Color fundus image; 45-degree field of view.
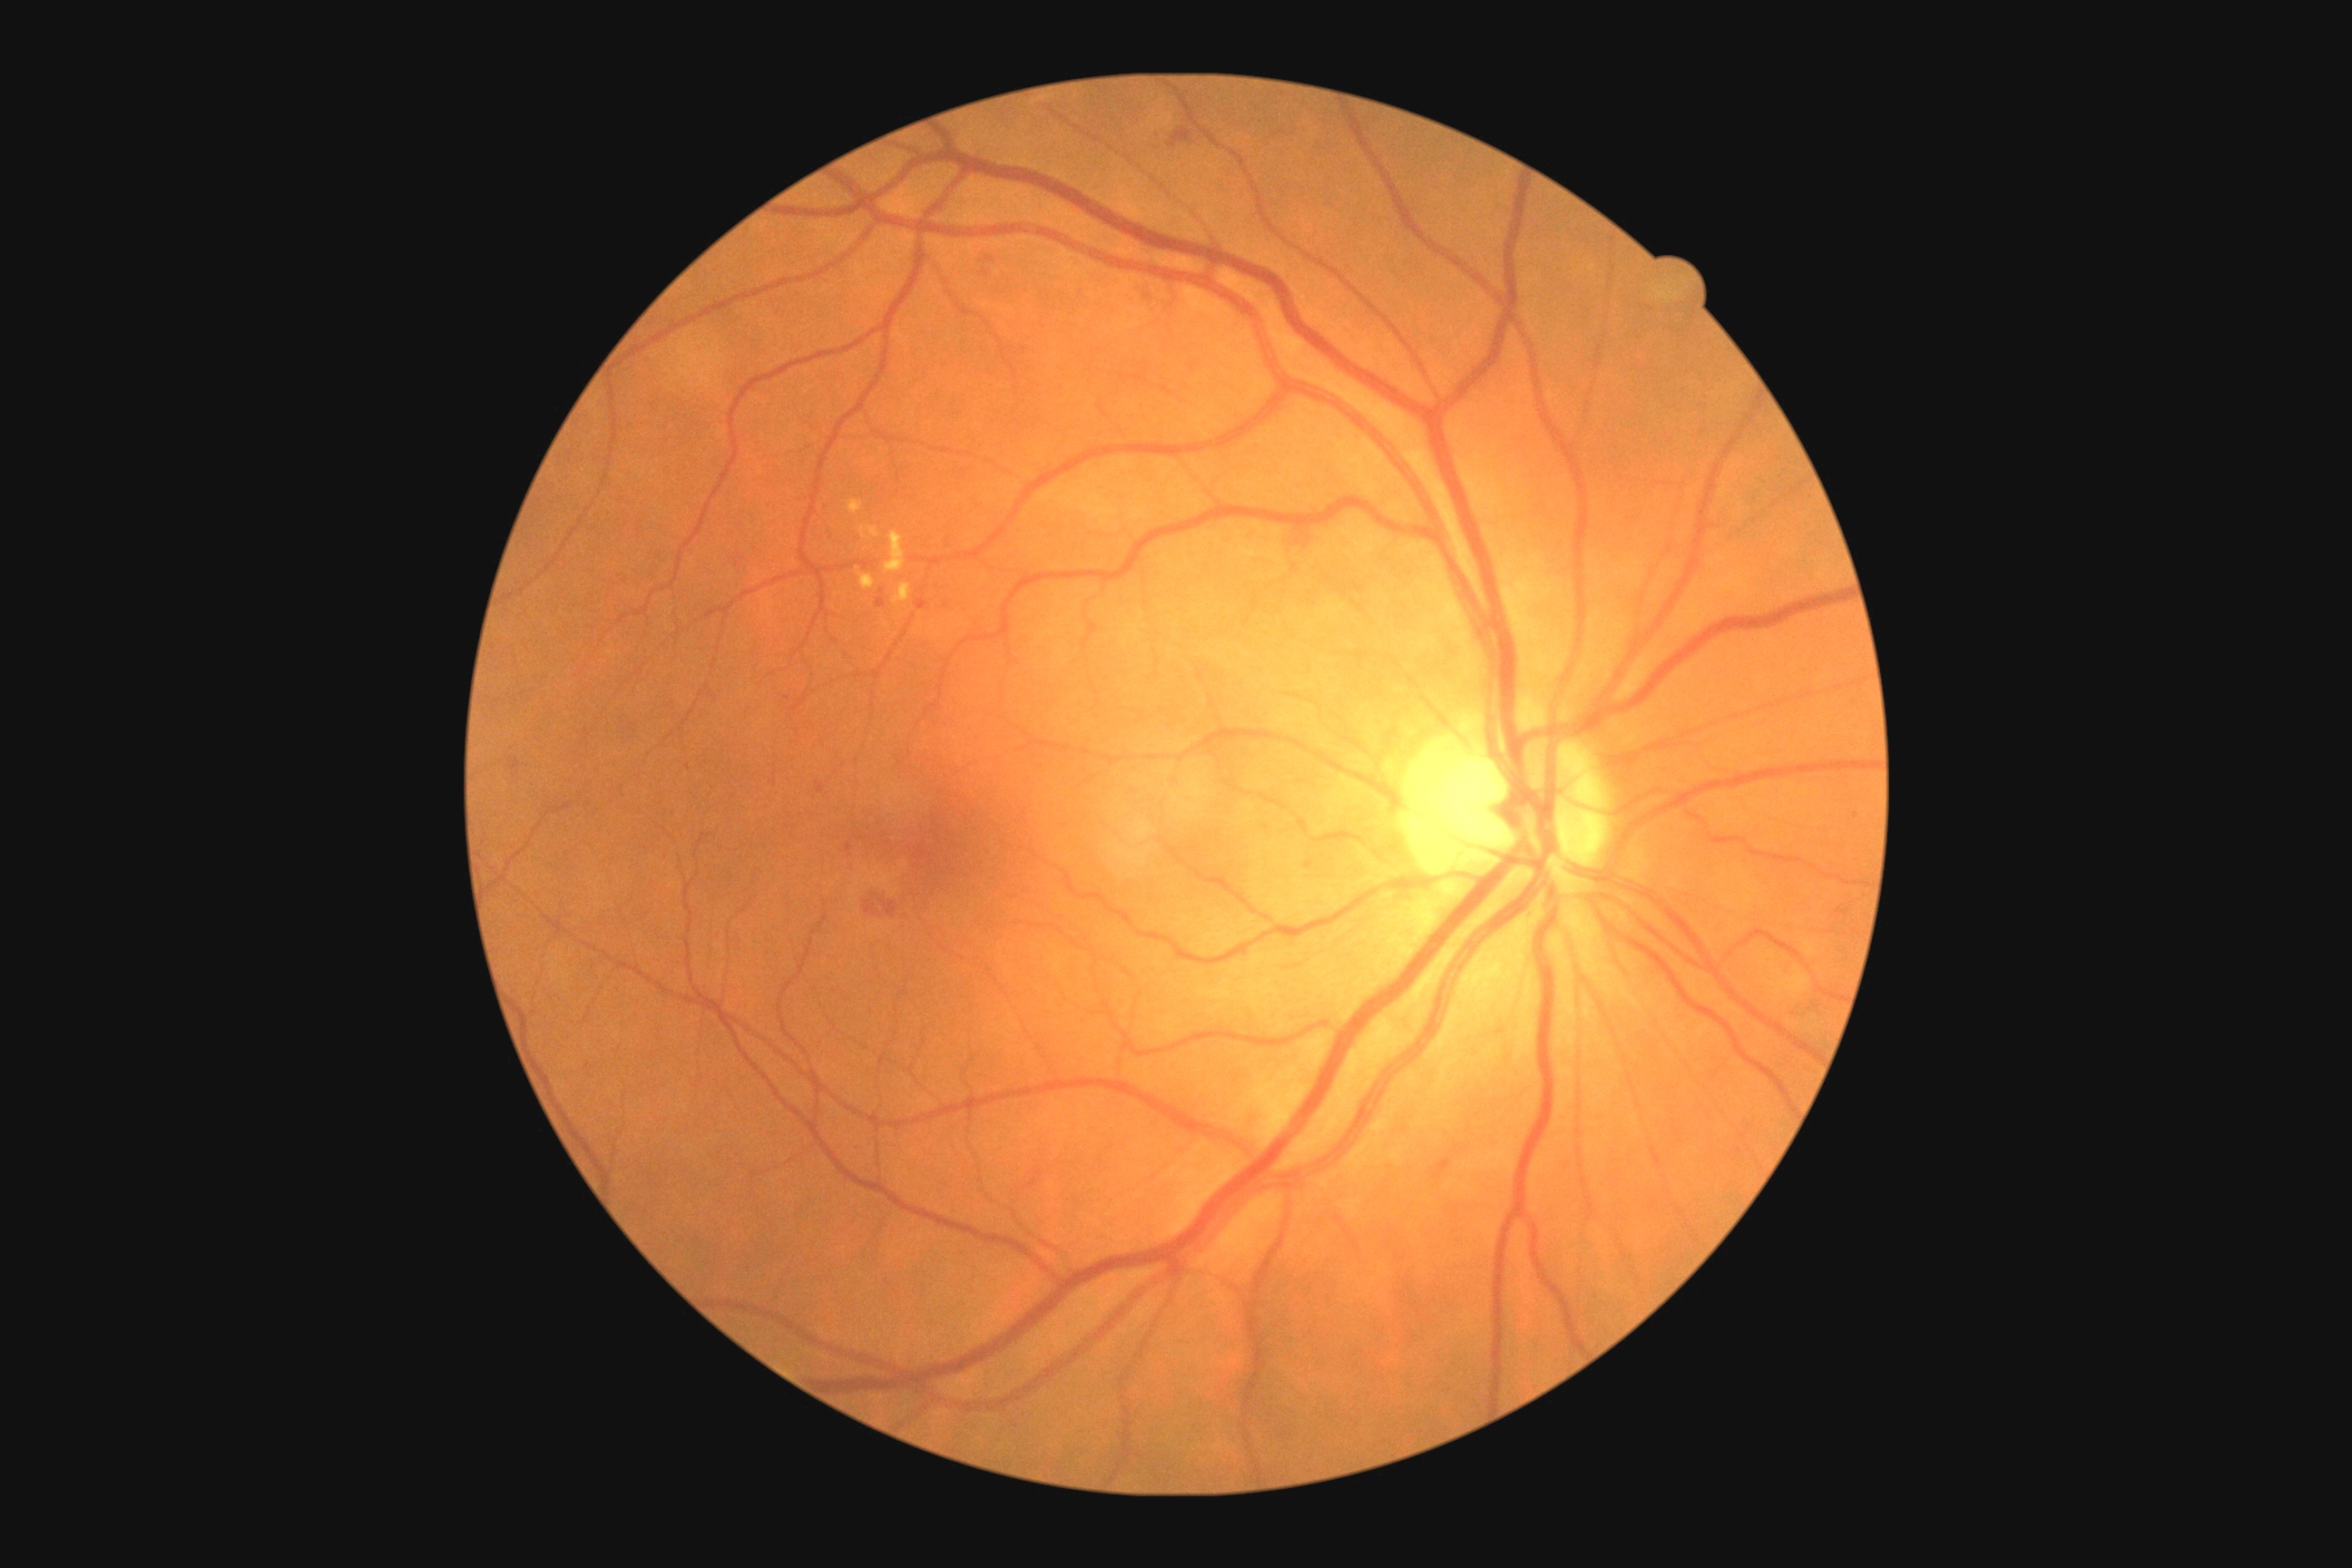
Diabetic retinopathy (DR): moderate non-proliferative diabetic retinopathy (grade 2). Hard exudates (EXs) located at <bbox>858, 567, 876, 591</bbox> | <bbox>847, 500, 865, 514</bbox> | <bbox>885, 533, 906, 574</bbox> | <bbox>892, 583, 912, 605</bbox> | <bbox>859, 527, 879, 538</bbox>. Microaneurysms (MAs) located at <bbox>876, 600, 887, 609</bbox> | <bbox>916, 600, 930, 611</bbox> | <bbox>816, 781, 823, 792</bbox>. Small MAs near 883:592 | 1856:815 | 1307:867 | 1088:782 | 849:848 | 987:277 | 787:698 | 689:767 | 987:259. Hemorrhages (HEs) located at <bbox>1293, 533, 1313, 551</bbox> | <bbox>981, 275, 994, 284</bbox> | <bbox>1135, 282, 1157, 309</bbox> | <bbox>509, 758, 522, 770</bbox> | <bbox>1436, 1159, 1451, 1173</bbox> | <bbox>859, 892, 906, 930</bbox> | <bbox>1168, 128, 1193, 148</bbox>. Small HEs near 1433:1169 | 1437:1176. No soft exudates (SEs) identified.